2212 by 1659 pixels:
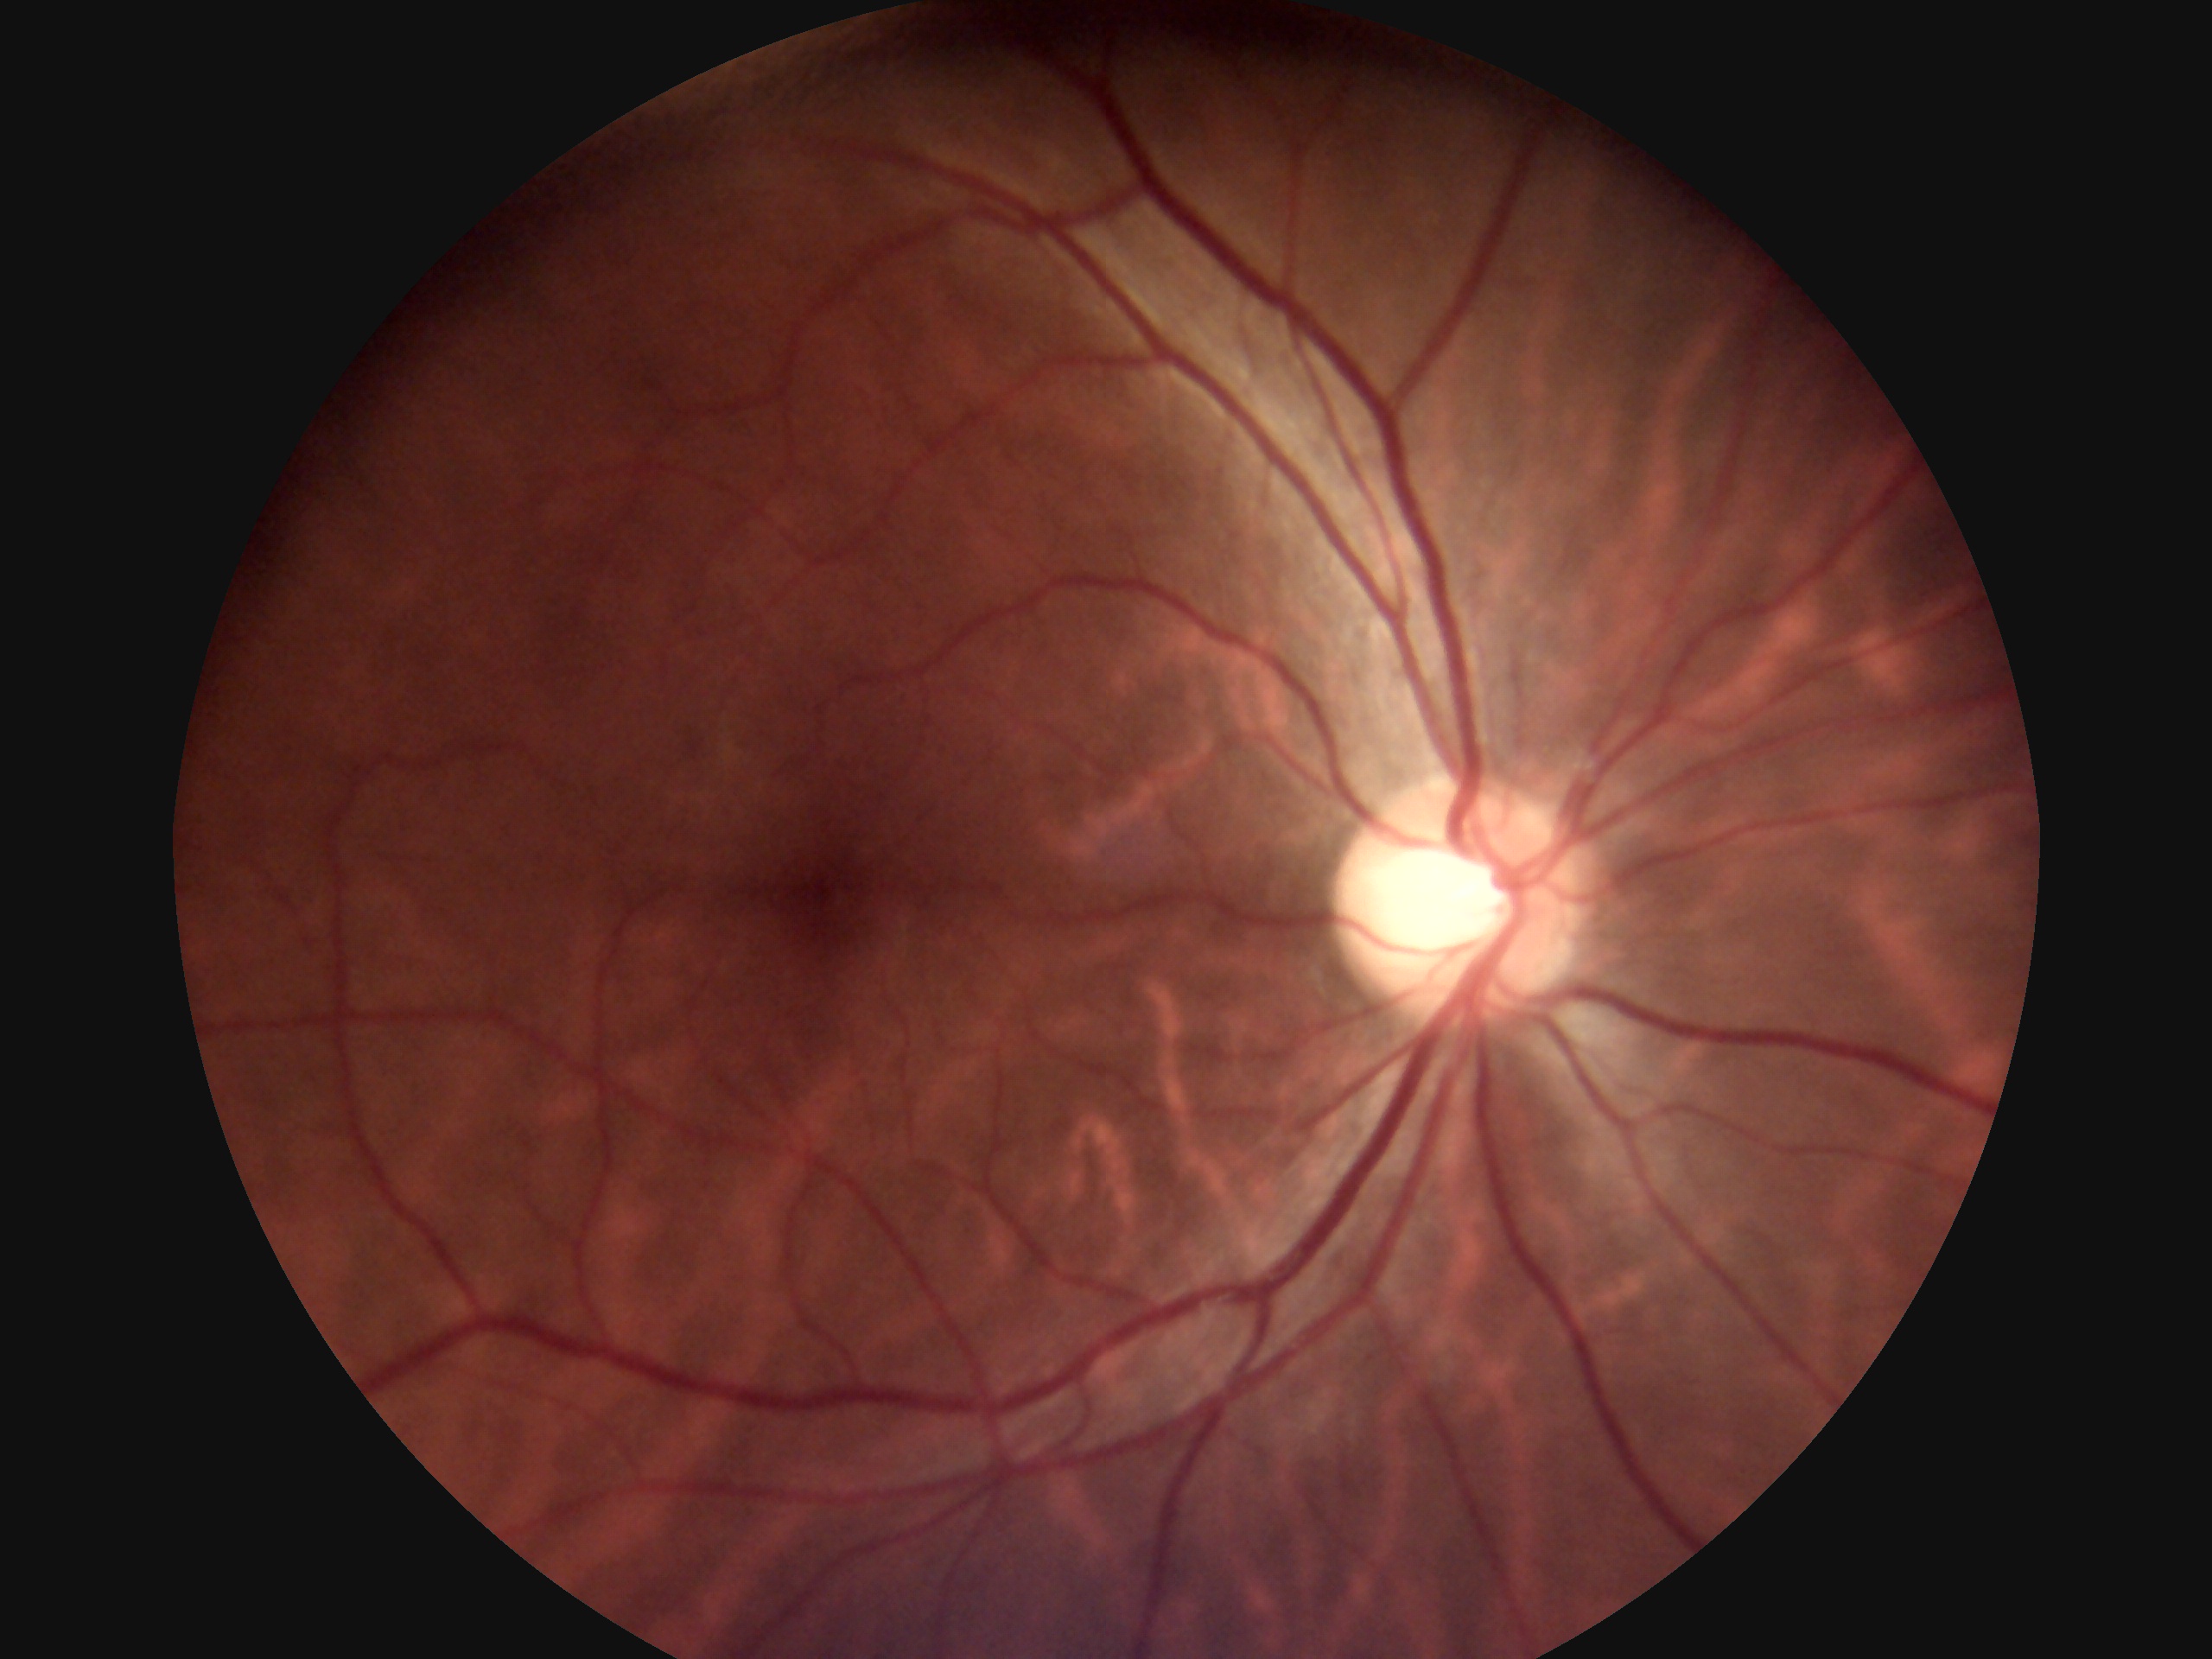

diabetic retinopathy (DR) = grade 0